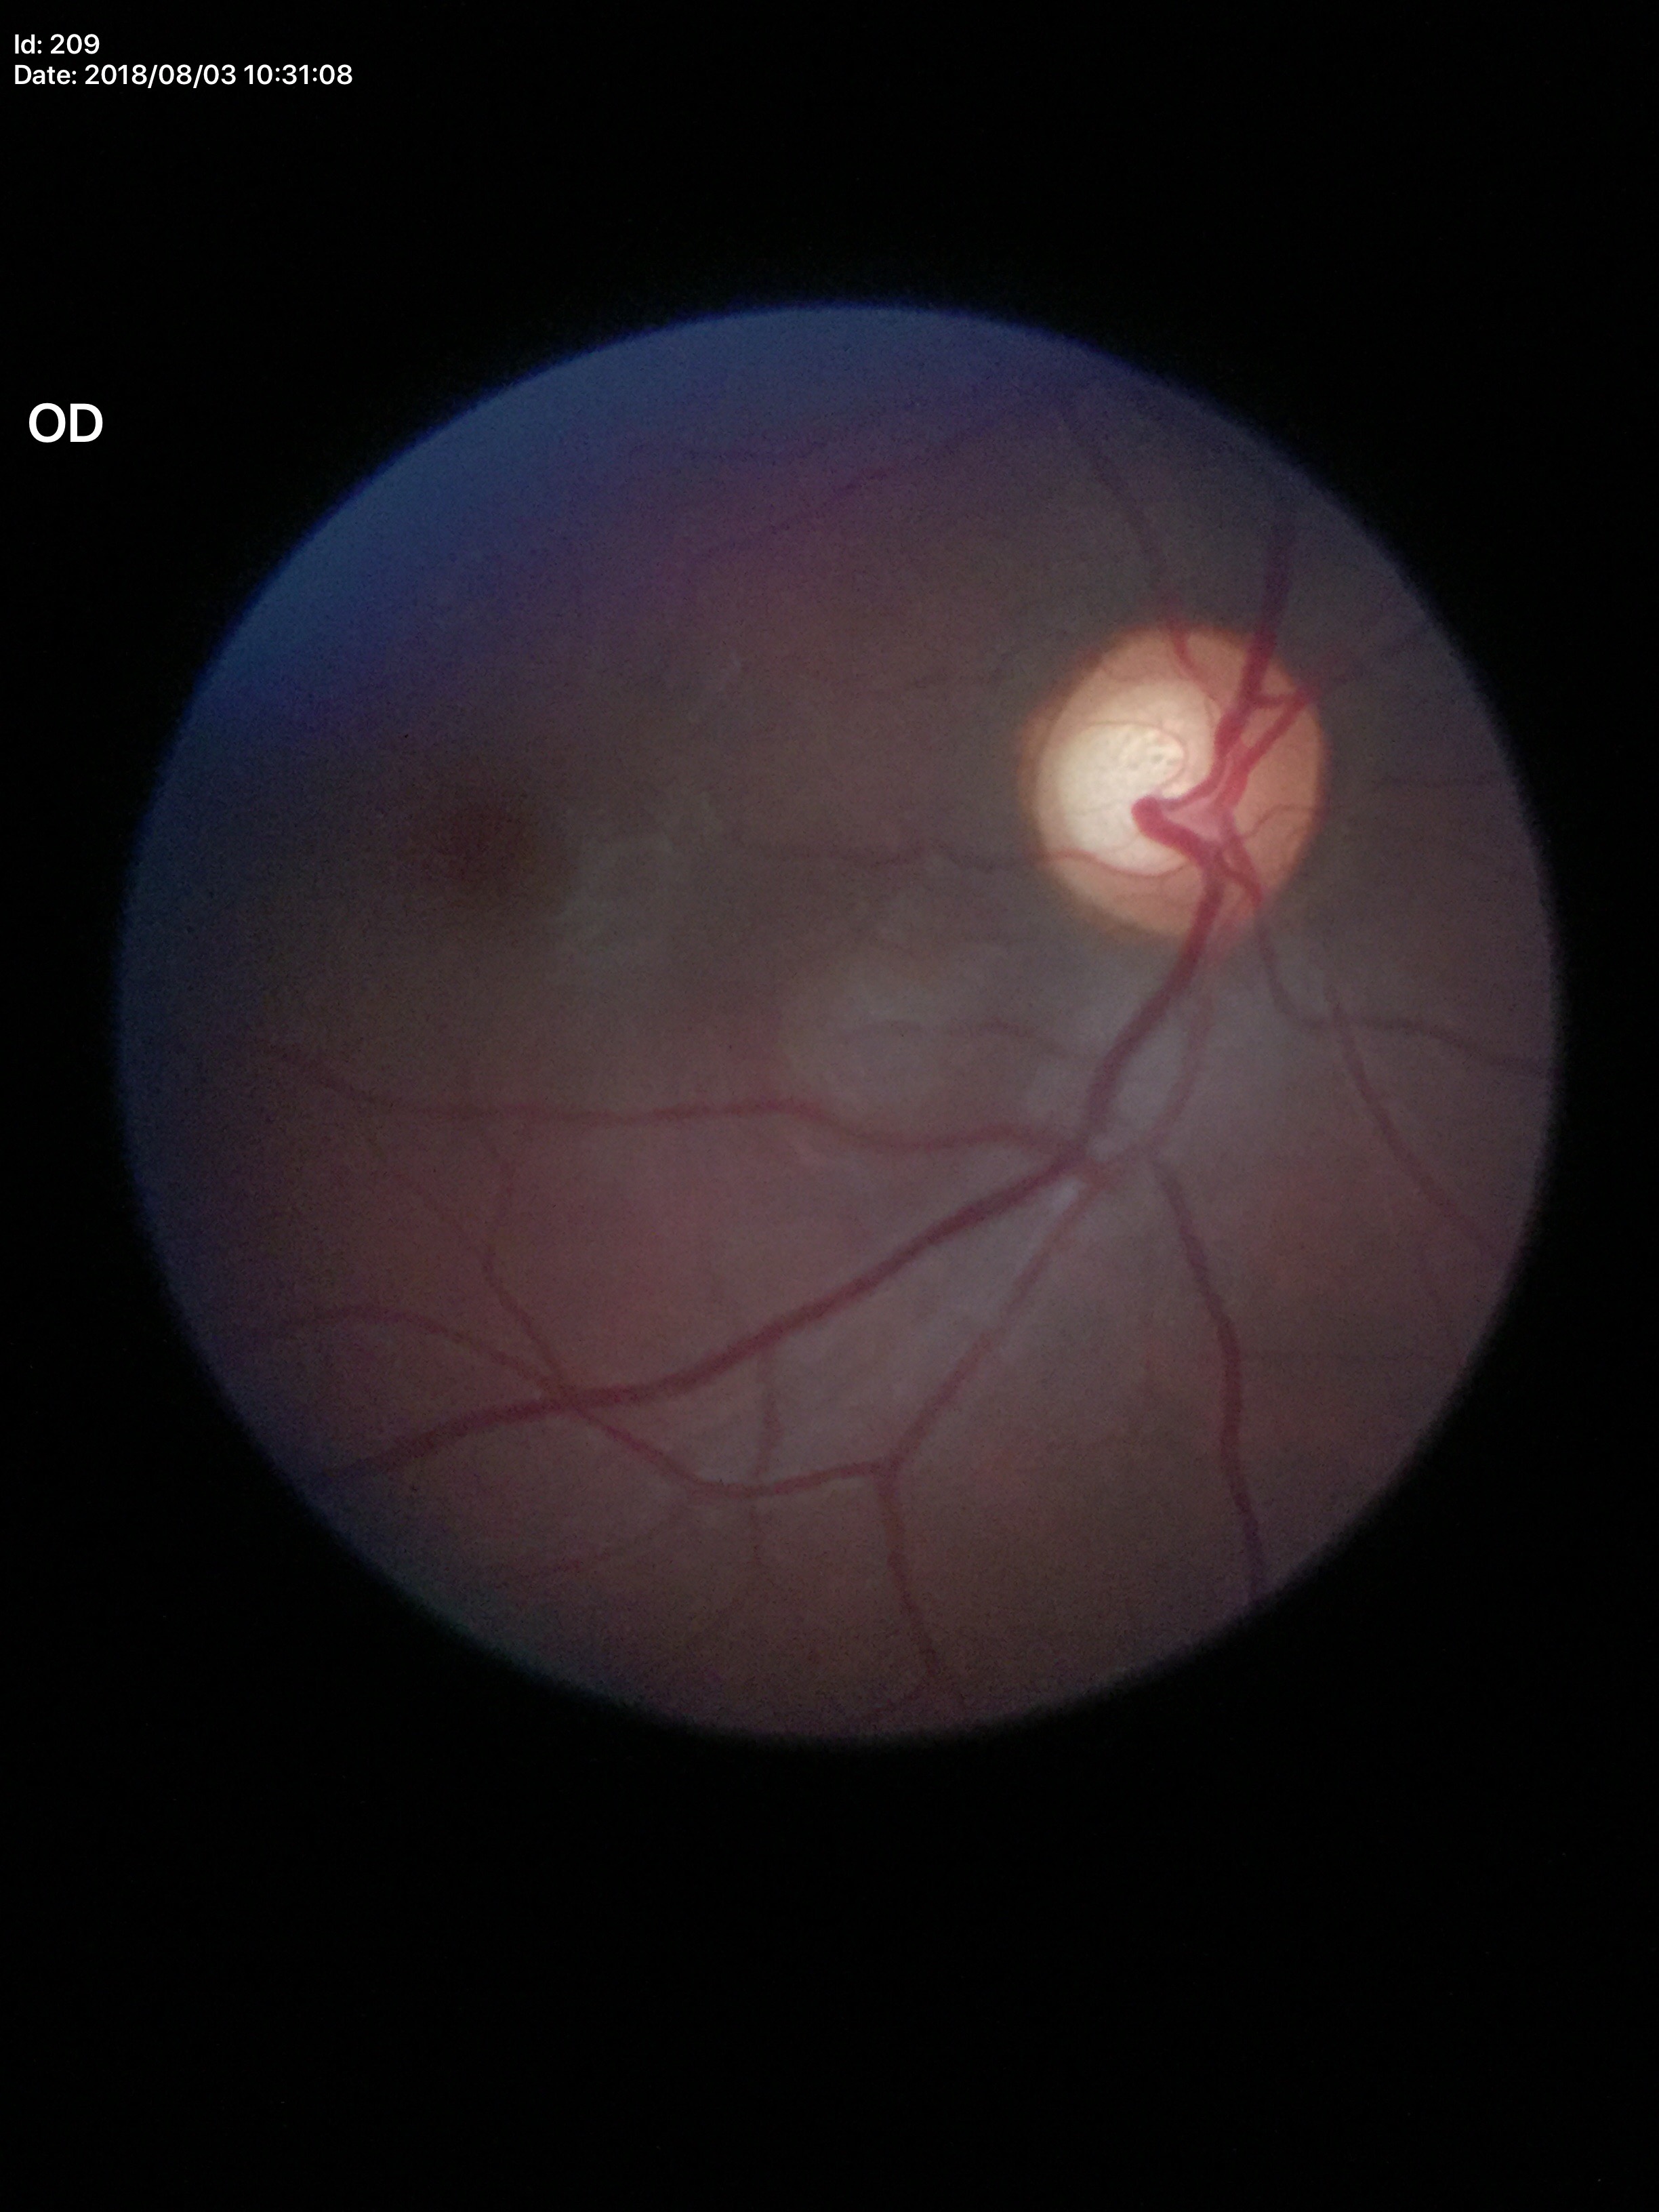
Glaucoma impression: suspect.
Vertical C/D ratio of 0.65.